45° field of view:
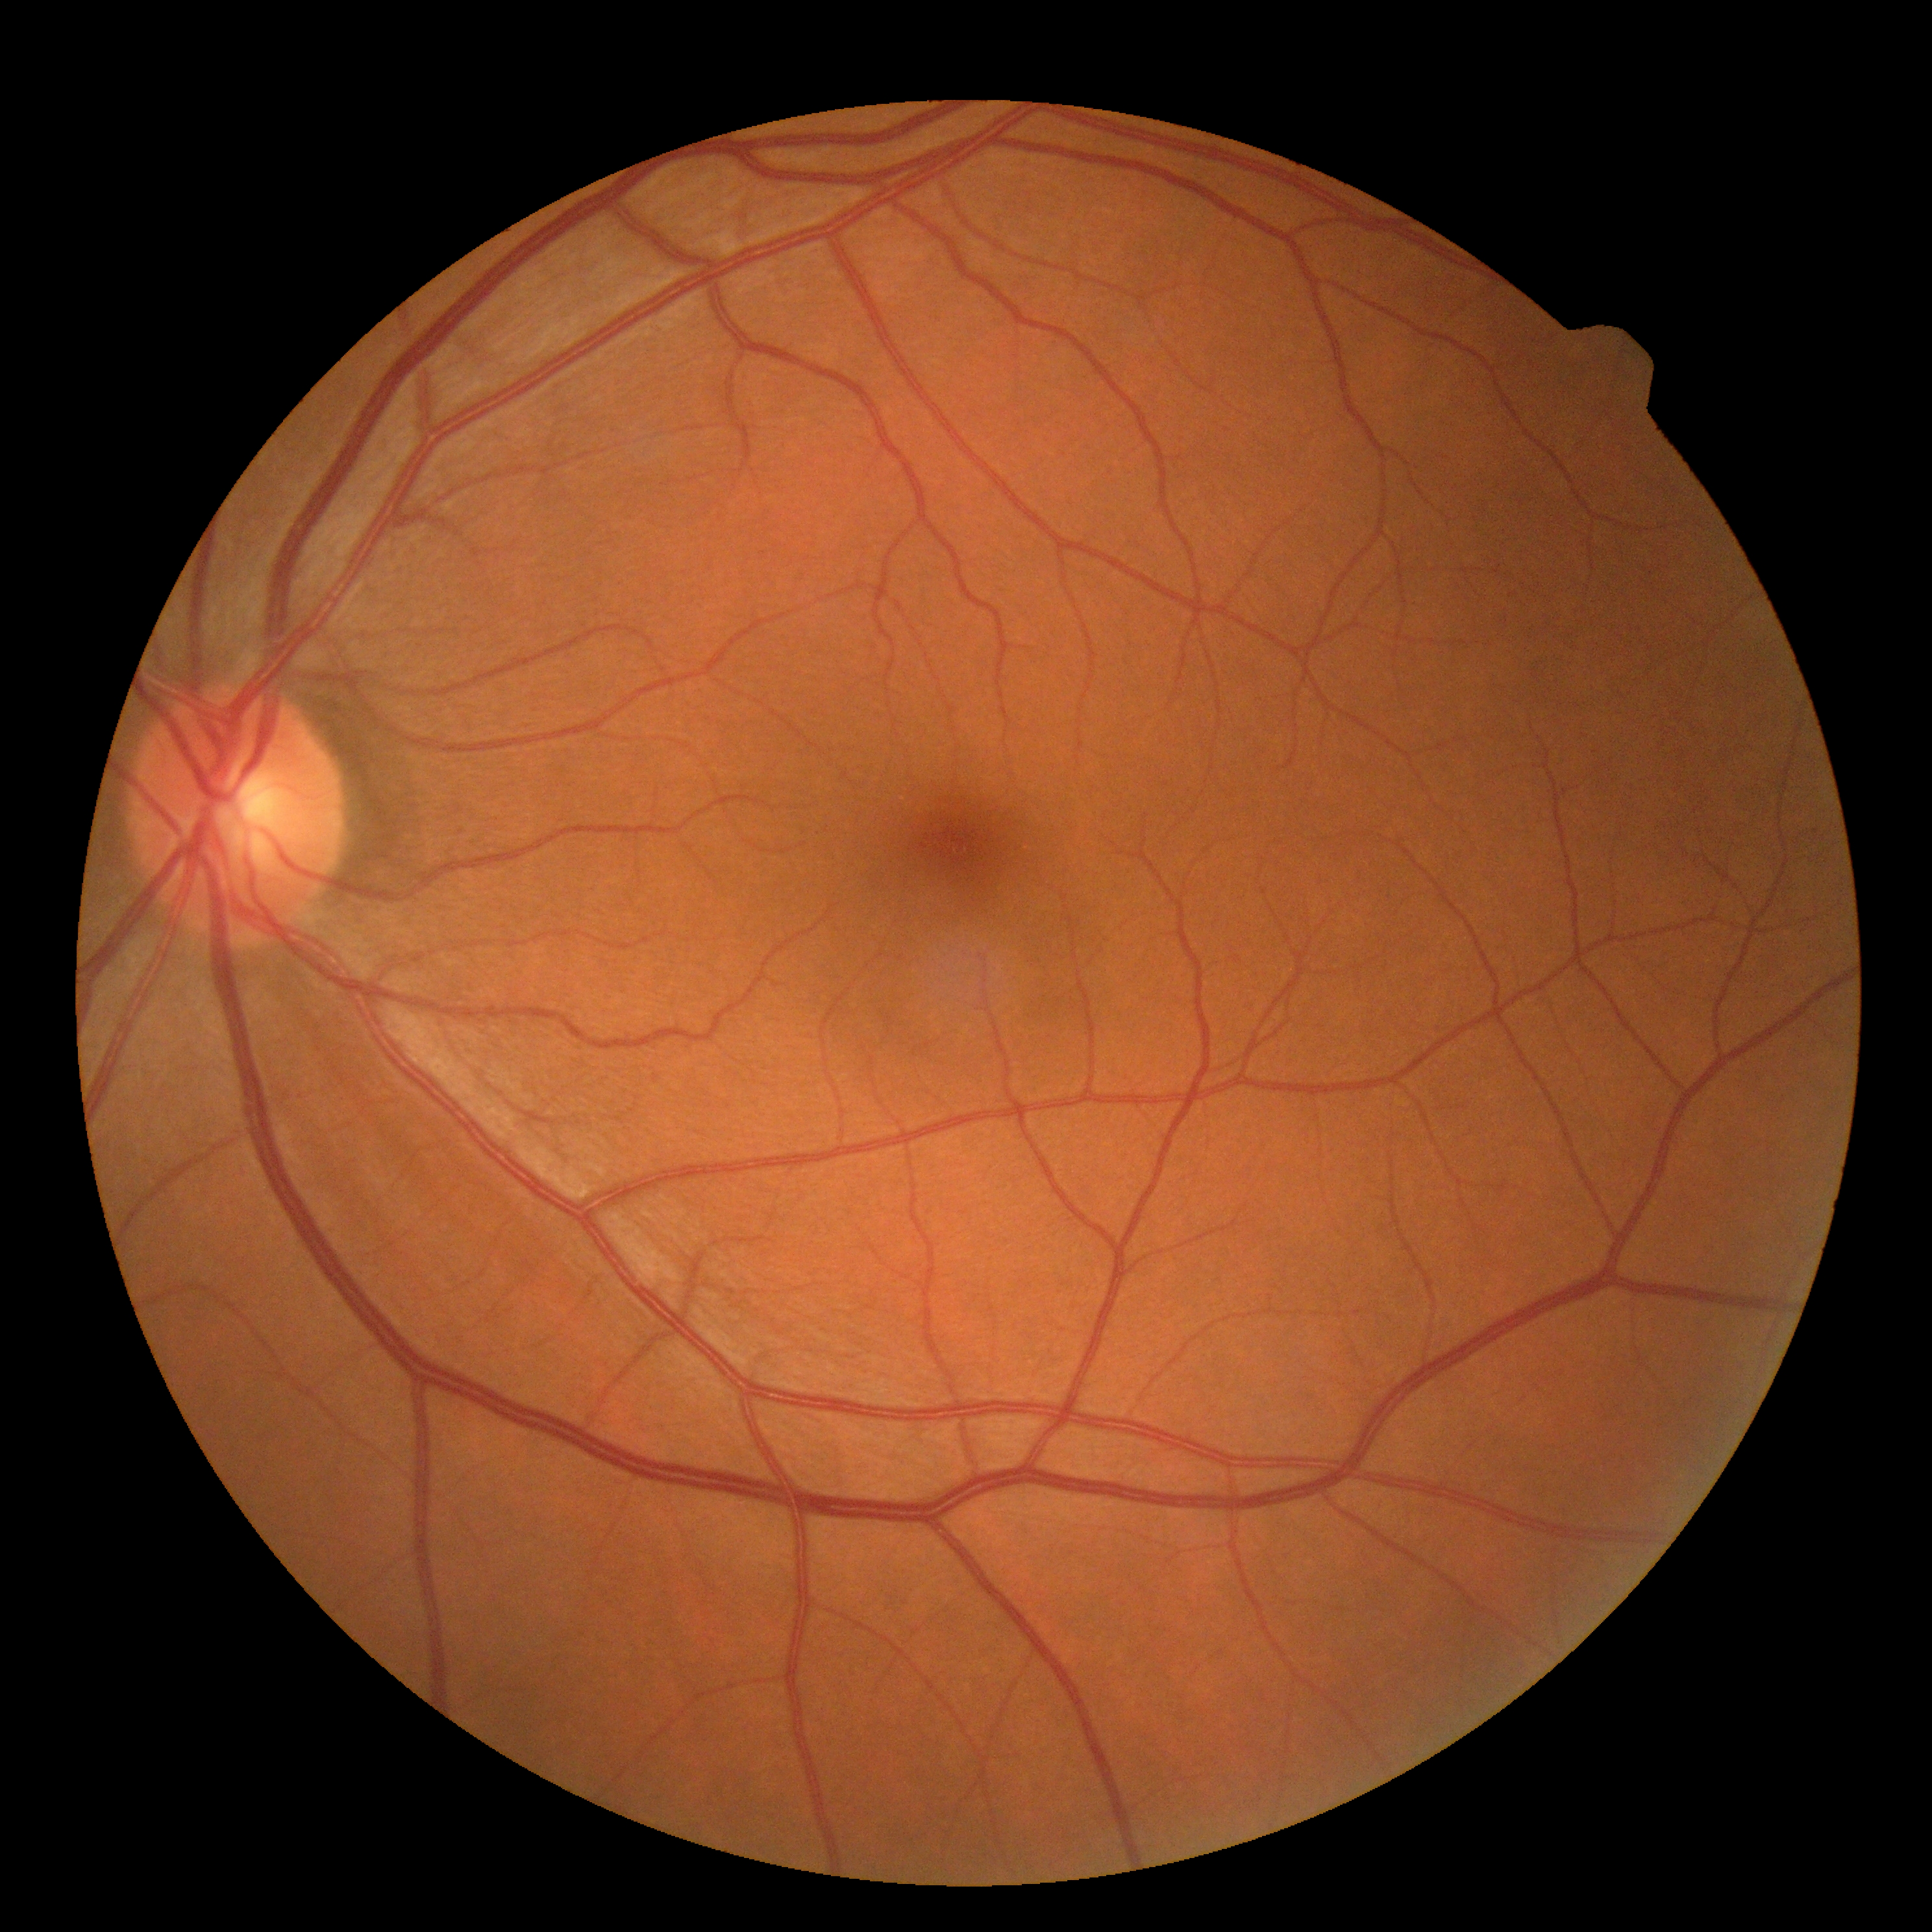
No signs of diabetic retinopathy. Retinopathy: 0/4 — no visible signs of diabetic retinopathy.